Camera: NIDEK AFC-230. 848 by 848 pixels: 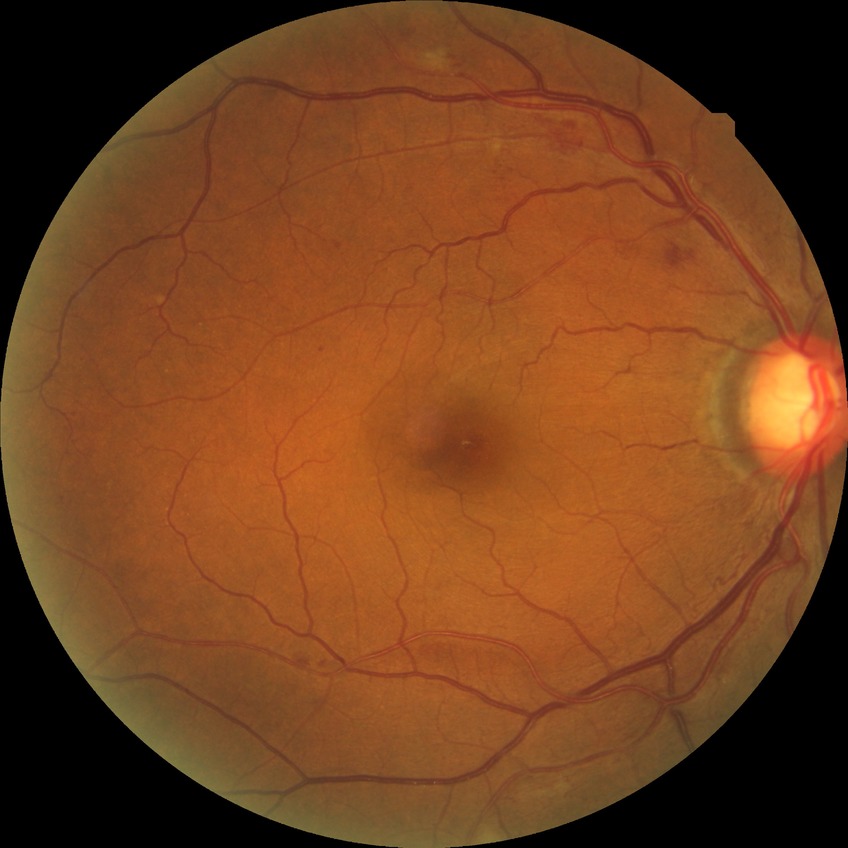
Davis stage is PPDR.